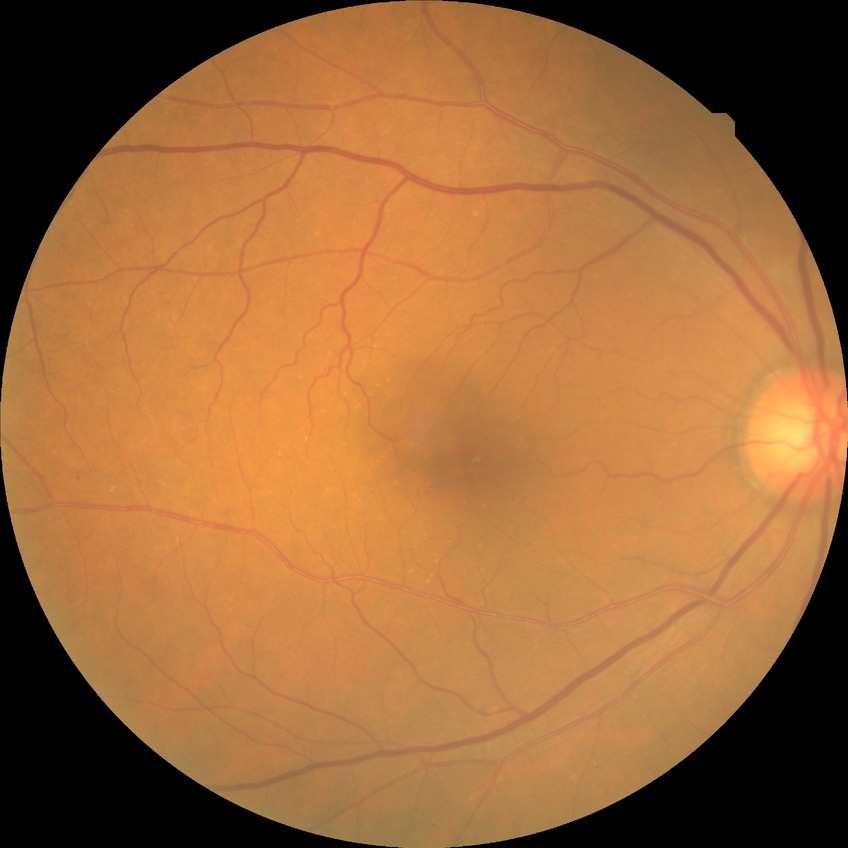

DR class: non-proliferative diabetic retinopathy, diabetic retinopathy severity: simple diabetic retinopathy.